640 by 480 pixels; wide-field contact fundus photograph of an infant — 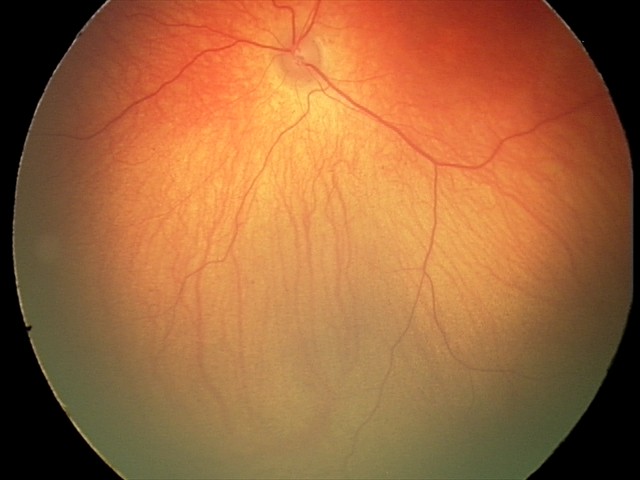

Finding = normal retinal appearance.